Acquired on the Clarity RetCam 3. Wide-field fundus photograph of an infant. 640 by 480 pixels:
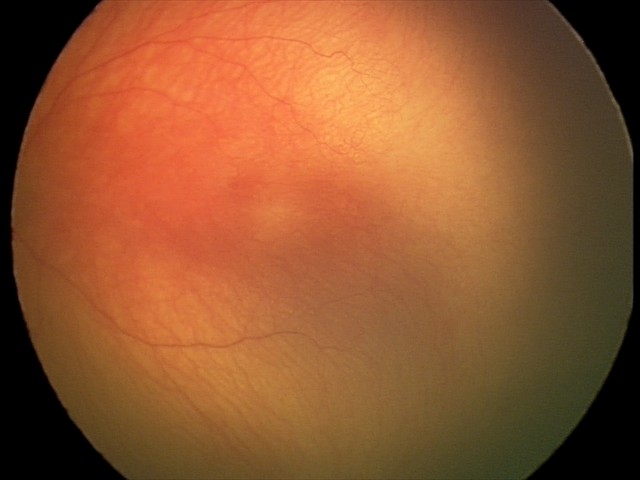
Screening examination consistent with aggressive retinopathy of prematurity.
With plus disease.